Captured with the Natus RetCam Envision (130° field of view). Wide-field fundus image from infant ROP screening: 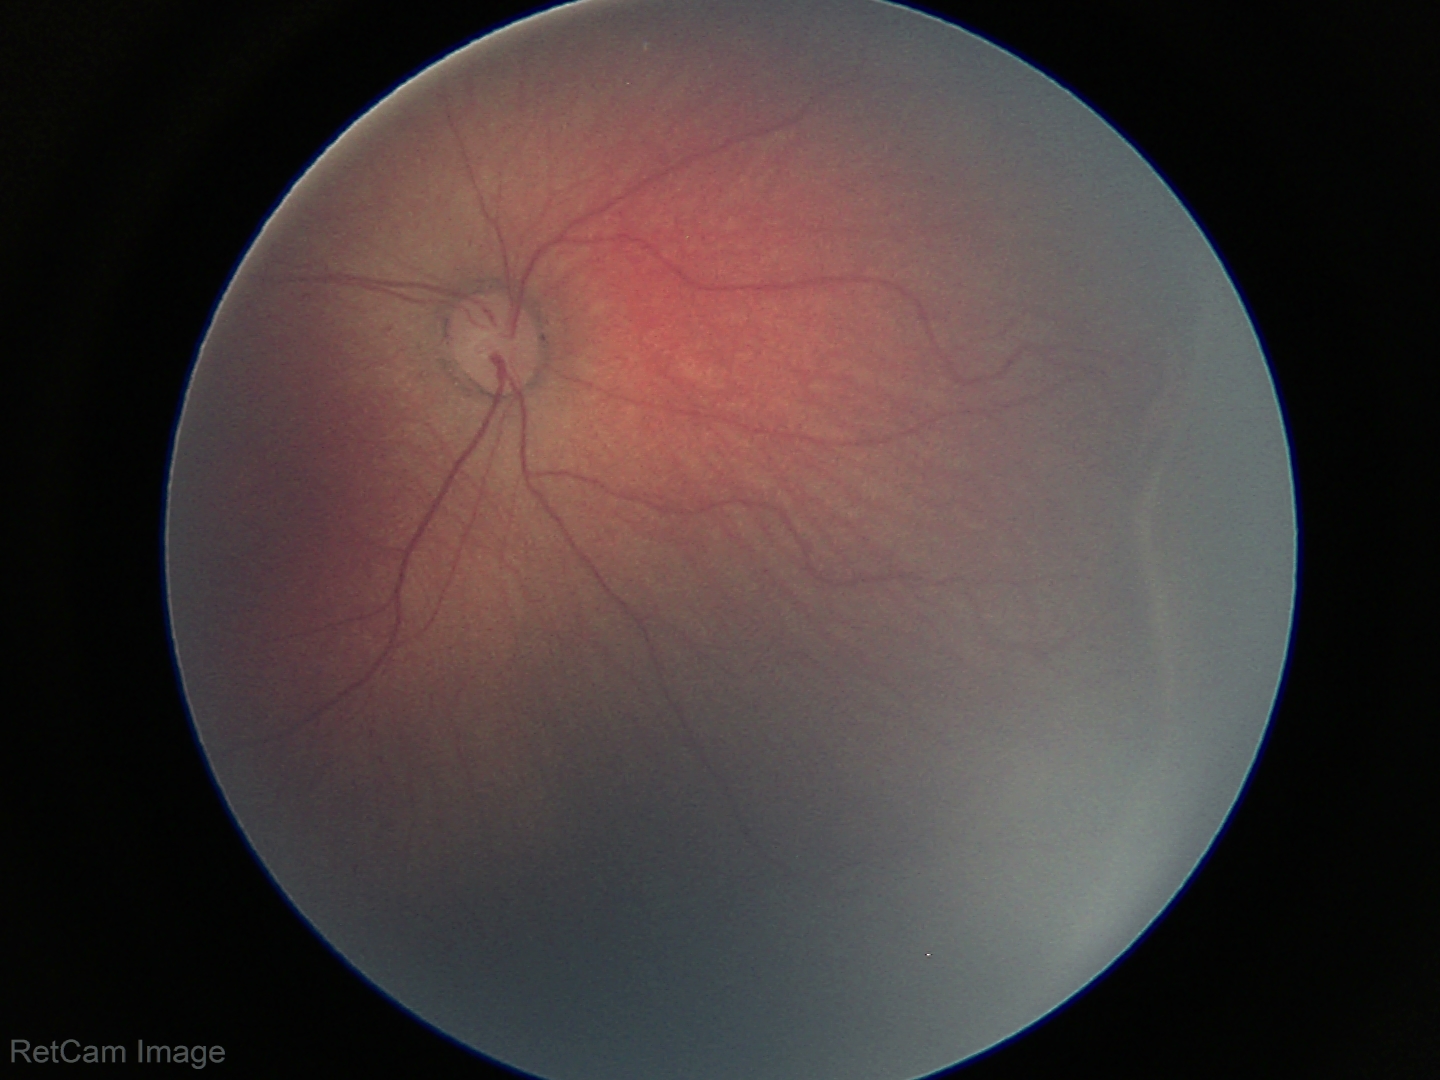
Assessment: retinopathy of prematurity stage 2 | no plus disease.